30° field of view · color fundus photograph — 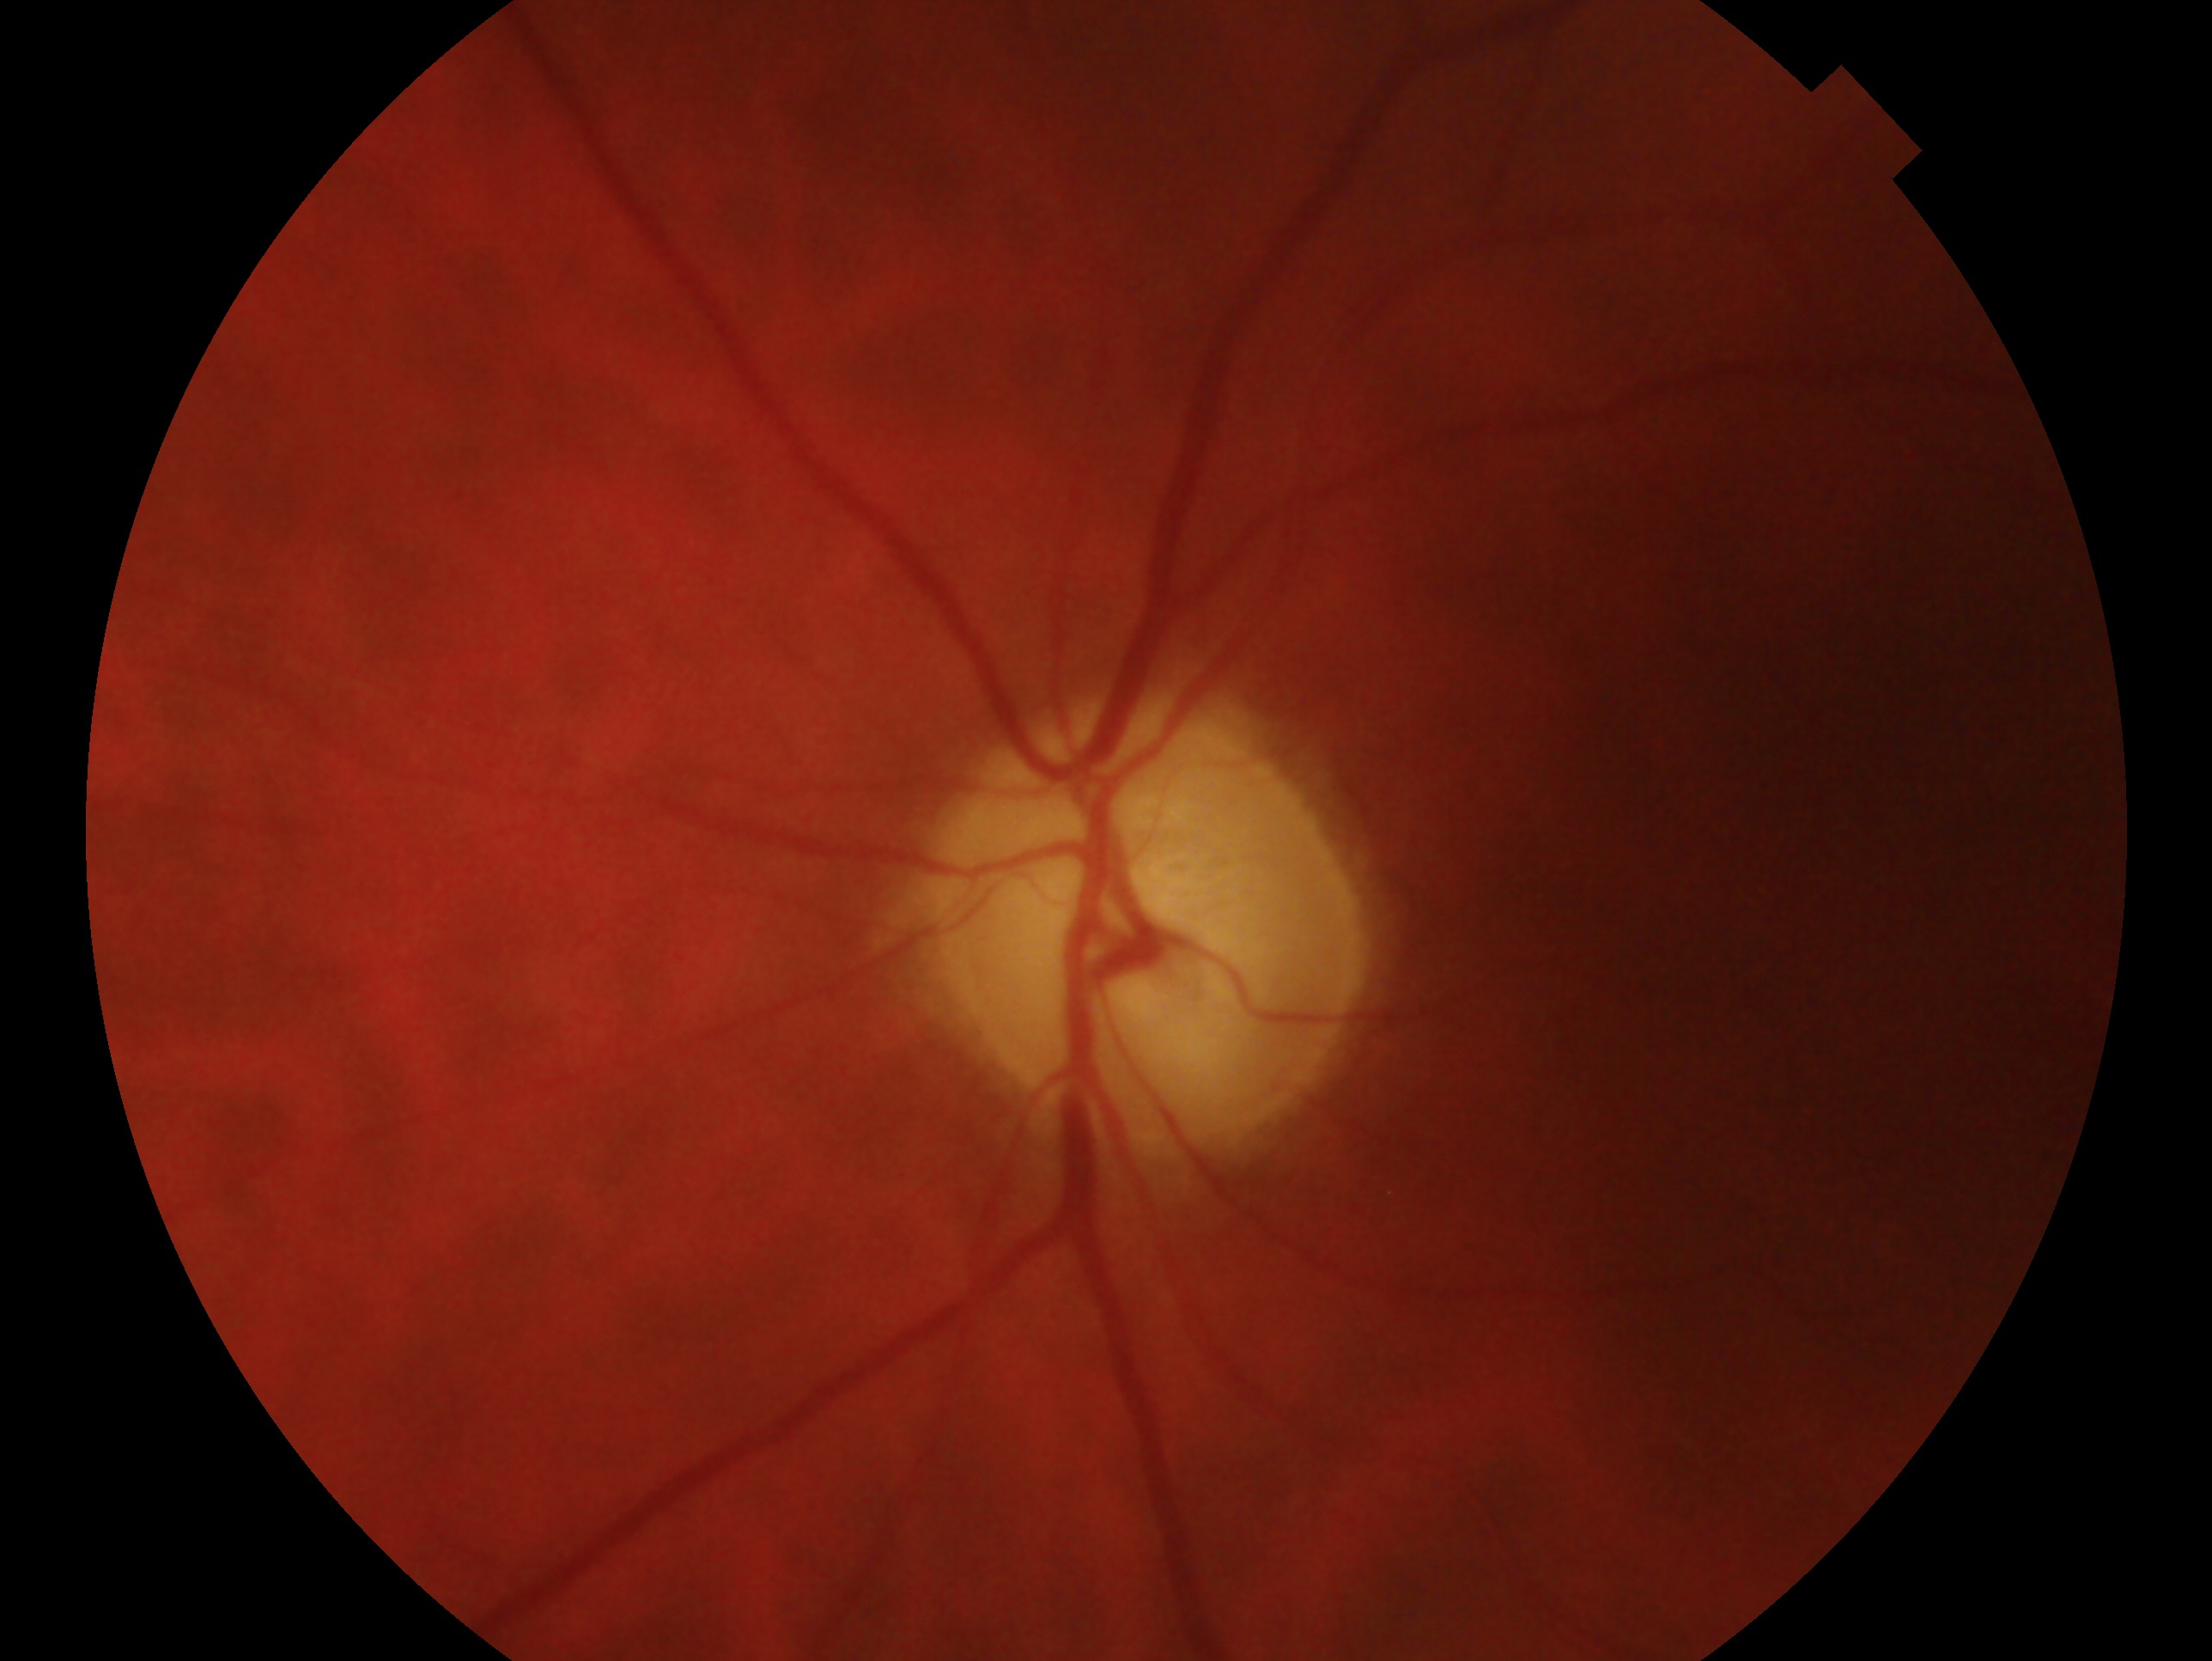   glaucoma_dx: consistent with glaucoma
  eye: left eye